Retinal fundus photograph: 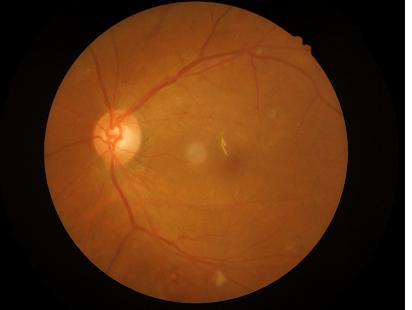

{
  "overall_quality": "satisfactory",
  "clarity": "good",
  "contrast": "adequate"
}